Wide-field fundus photograph of an infant:
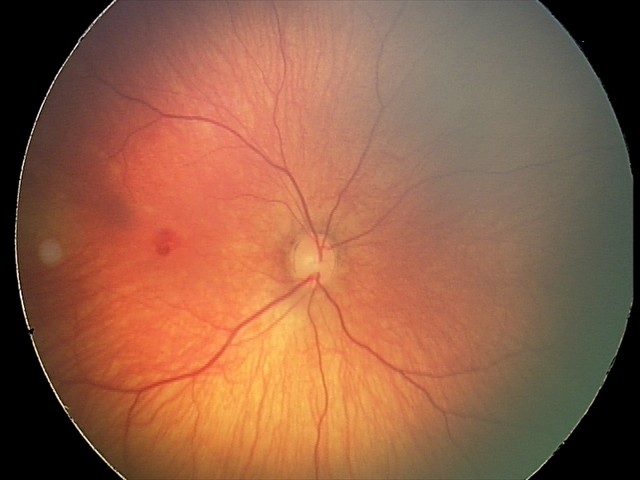

Series diagnosed as retinal hemorrhages.